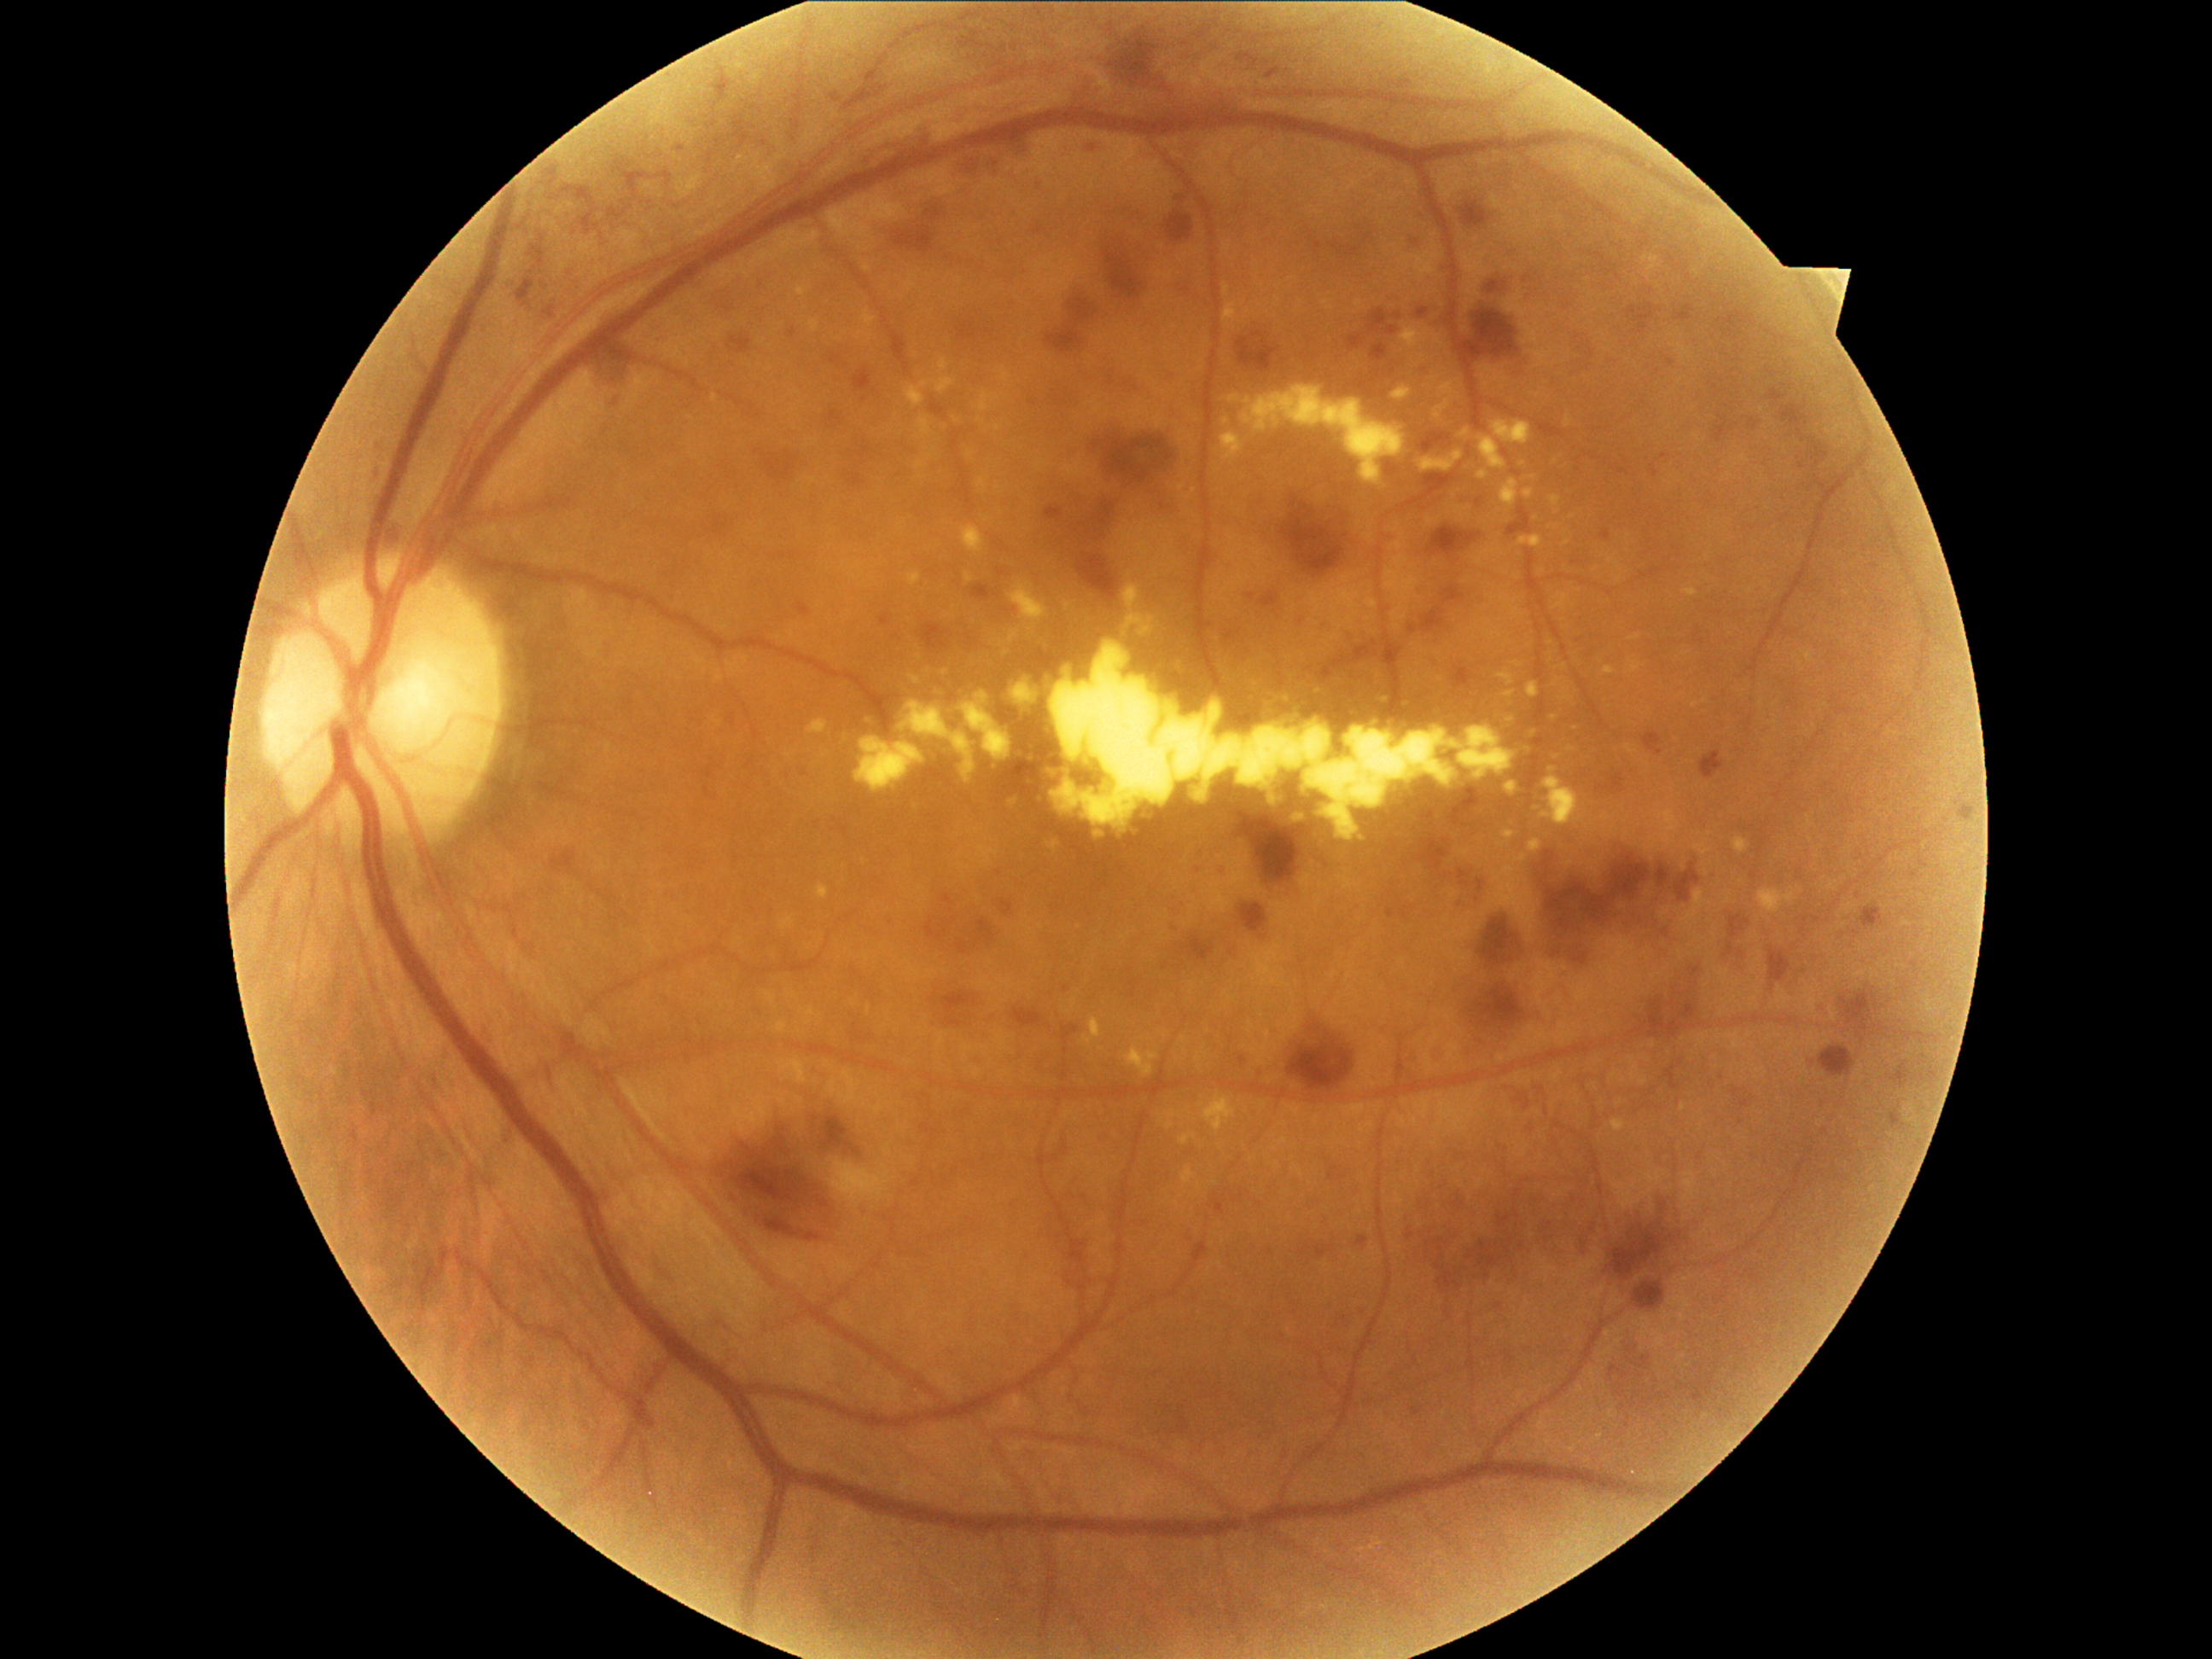
{"partial":true,"dr_grade":3,"dr_grade_name":"severe NPDR","lesions":{"he":[[1467,1226,1522,1283],[1076,76,1098,107],[796,602,812,617],[1417,429,1452,457],[940,989,981,1028],[1037,224,1047,235],[1496,1209,1520,1228],[1315,641,1377,673],[1371,342,1388,361],[1238,899,1267,934],[1109,428,1179,480],[1175,914,1184,933],[1458,672,1464,680],[1803,438,1831,469],[1889,1112,1906,1134],[1503,521,1520,533]],"he_small":[[378,475]]}}